Image size 640x480; wide-field fundus image from infant ROP screening; Clarity RetCam 3, 130° FOV — 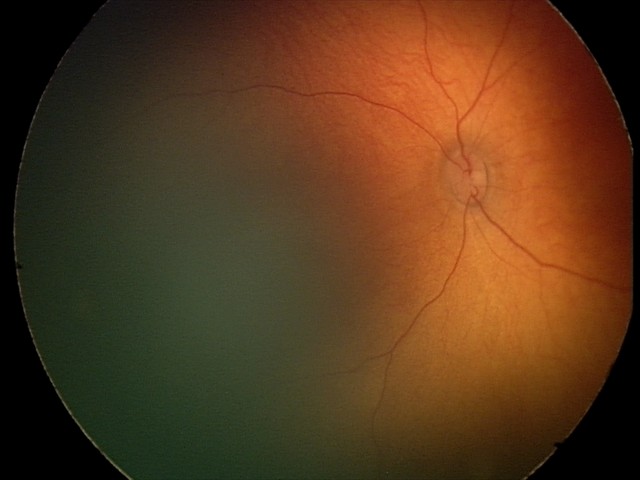 No retinal pathology identified on screening.